Nidek AFC-330:
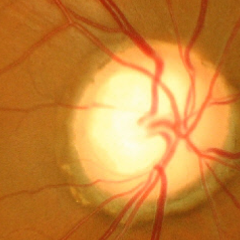

Demonstrates advanced glaucomatous optic neuropathy.